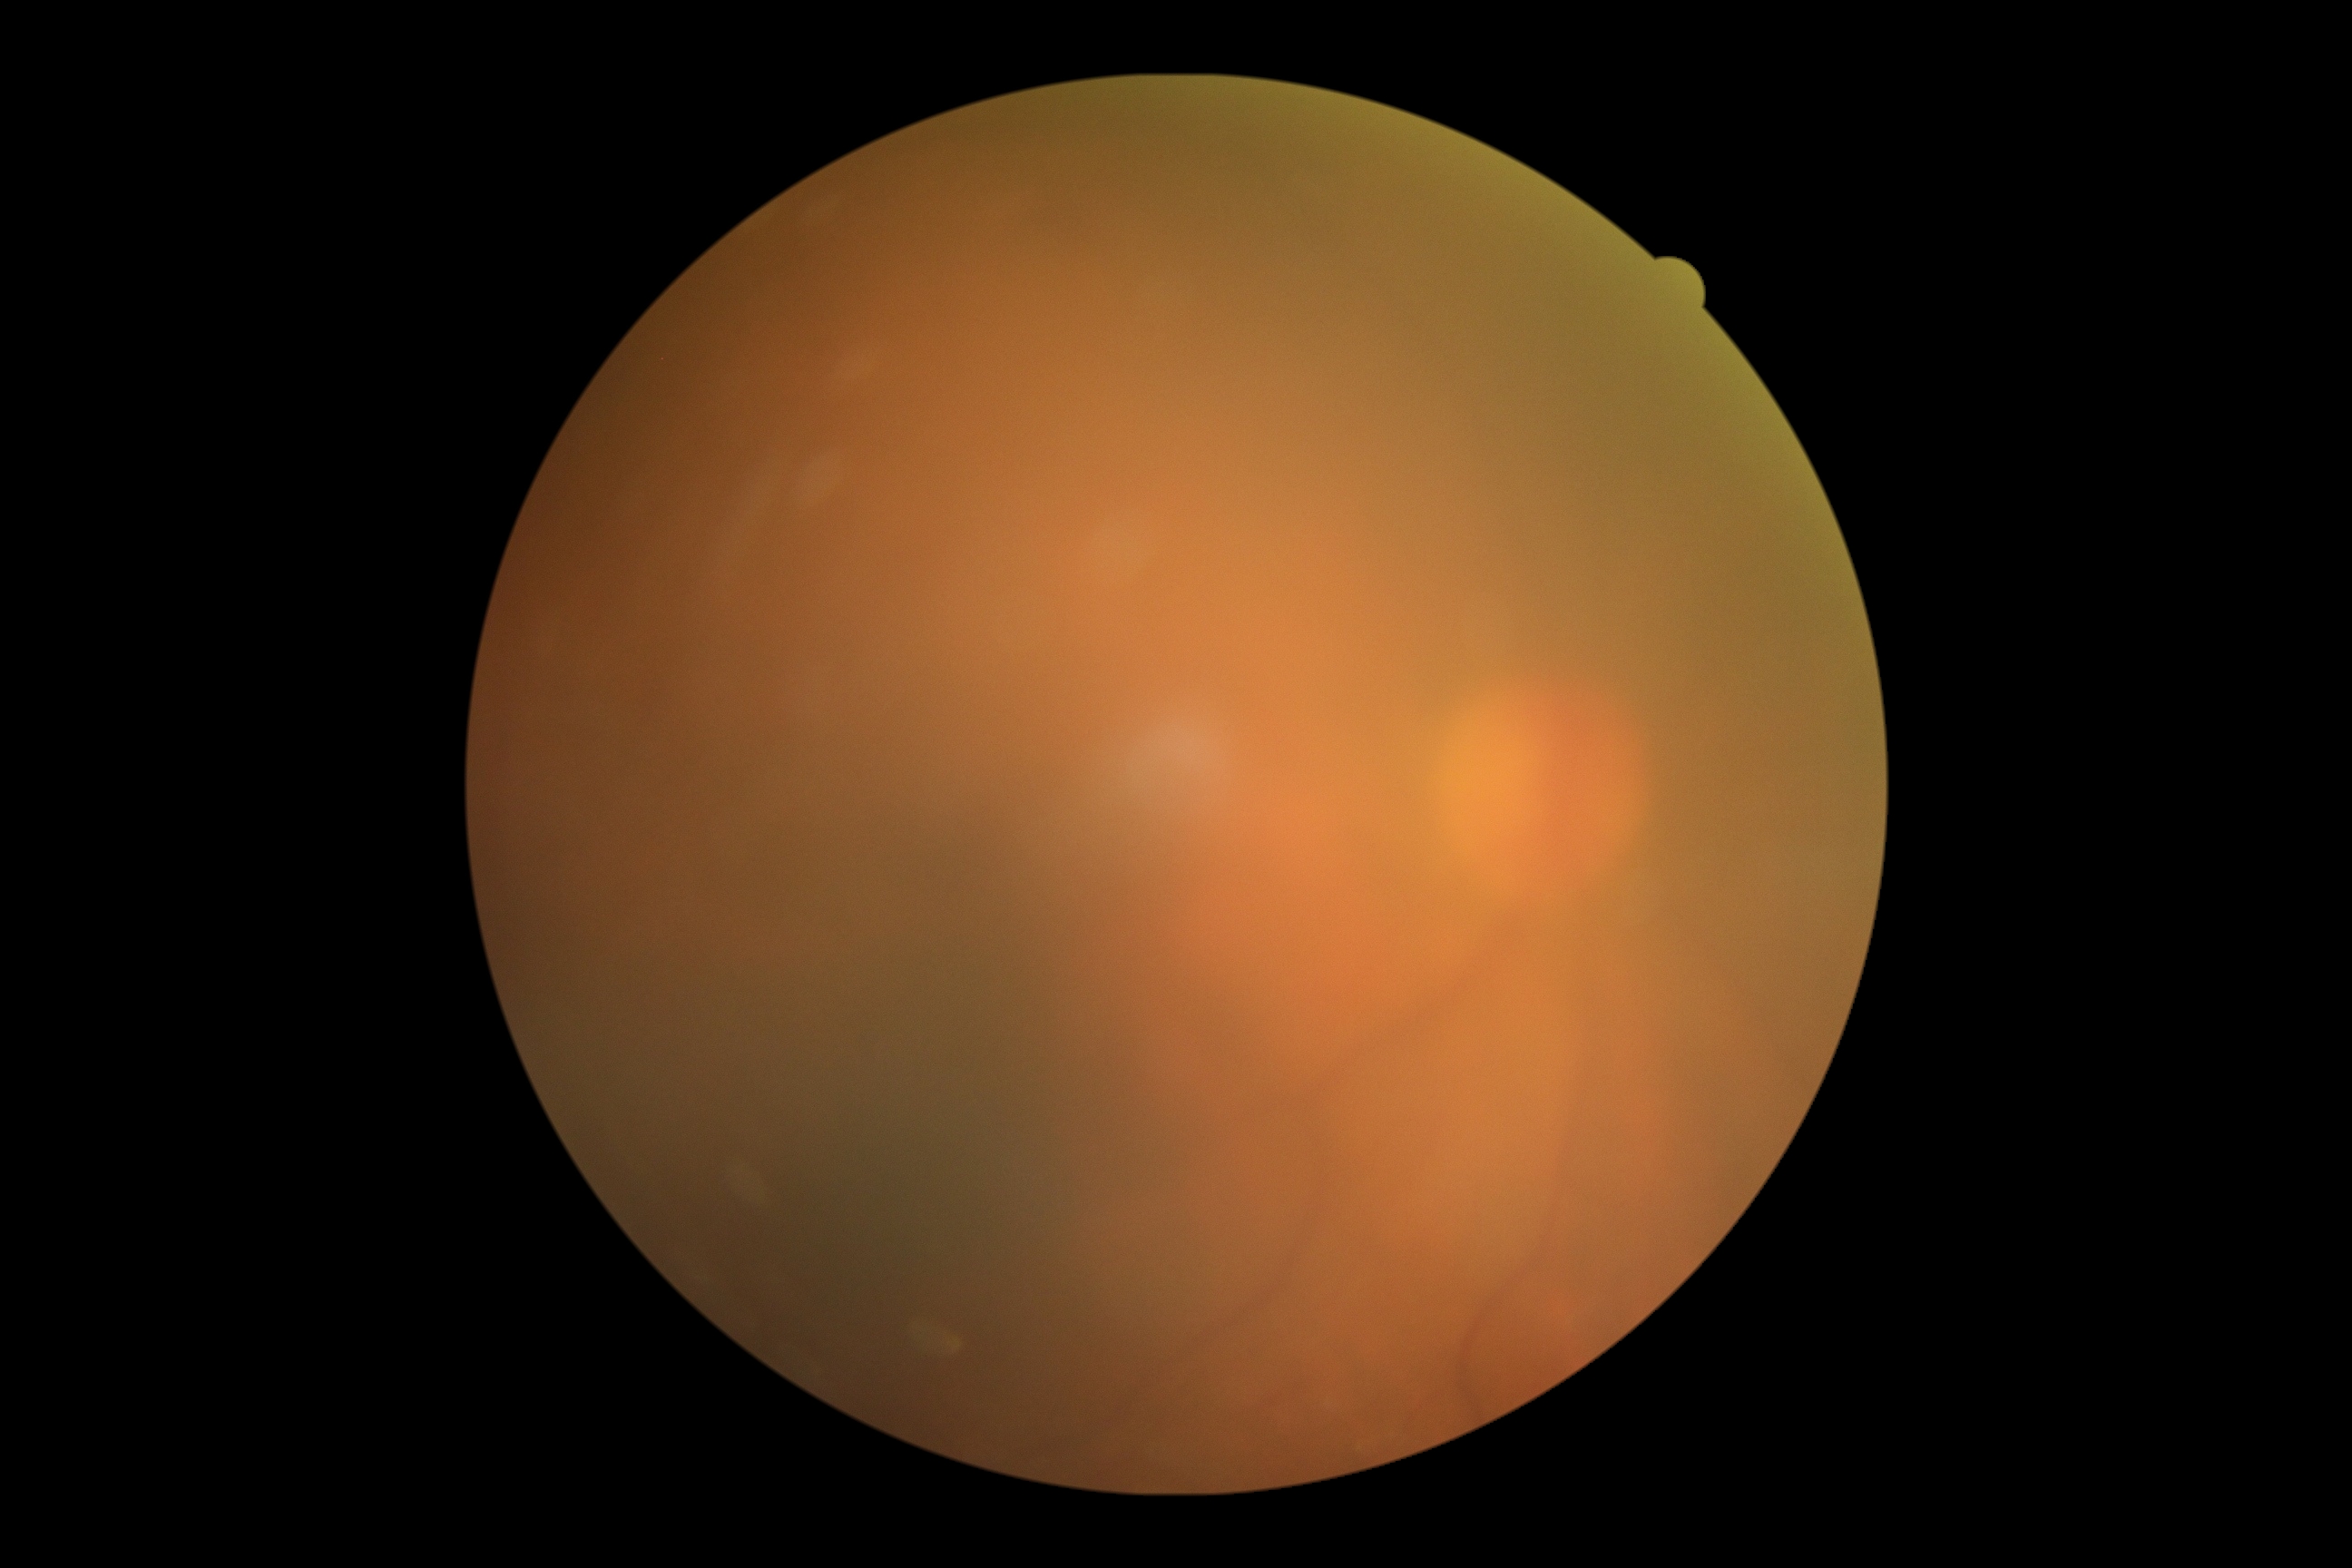

{"dr_grade": "ungradable due to poor image quality"}